45° FOV; modified Davis classification
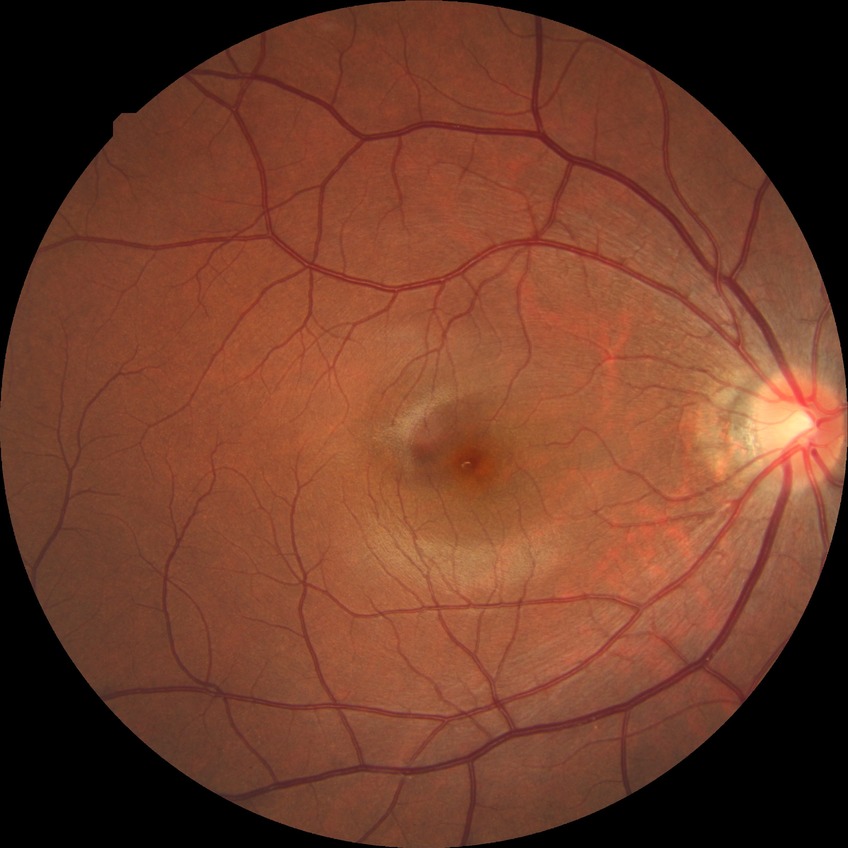
Diabetic retinopathy (DR): NDR (no diabetic retinopathy).